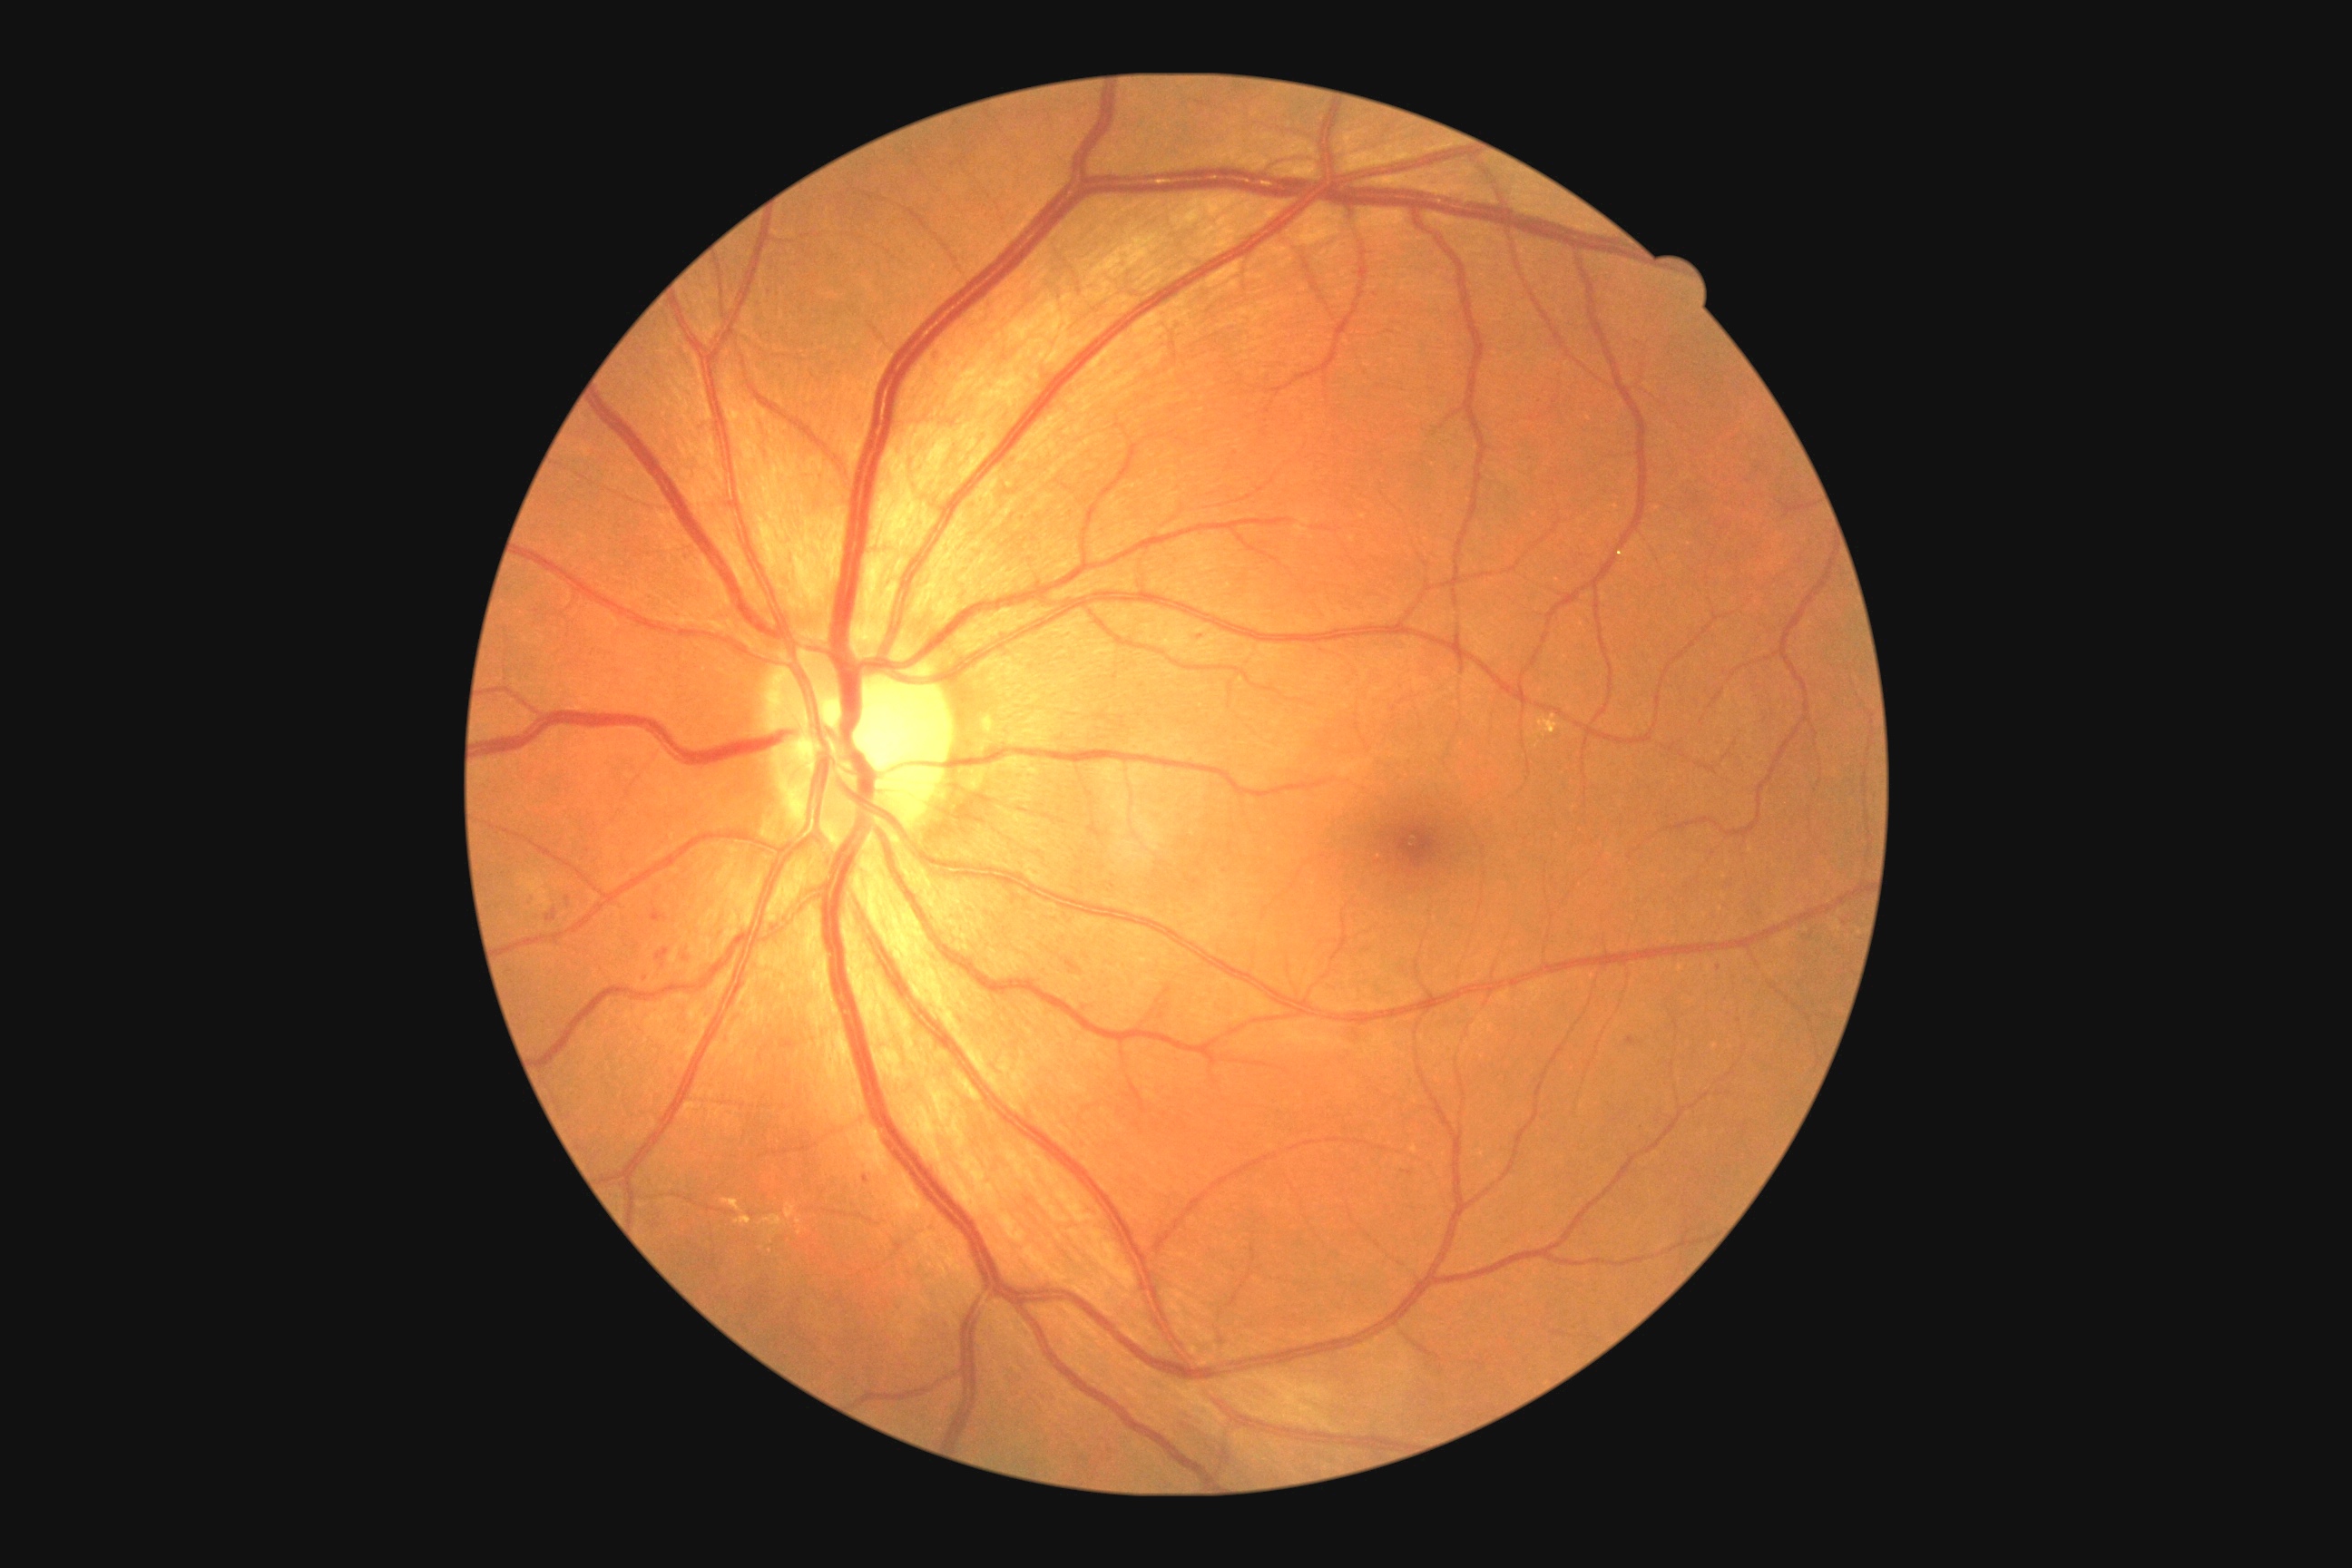 Diabetic retinopathy is moderate non-proliferative diabetic retinopathy (grade 2) — more than just microaneurysms but less than severe NPDR
A subset of detected lesions:
soft exudates: none
hard exudates (more not shown): [734,1215,752,1226] | [1534,714,1560,738] | [721,1199,743,1213] | [787,1202,796,1219] | [760,1215,787,1235]
Small hard exudates approximately at <point>770, 1251</point> | <point>799, 1221</point> | <point>1537, 746</point> | <point>800, 1232</point>
microaneurysms: [1199,634,1208,643] | [1627,1037,1636,1044] | [865,1175,870,1184] | [936,351,946,366]
Small microaneurysms approximately at <point>645, 979</point> | <point>1719, 968</point> | <point>1845, 923</point> | <point>568, 899</point>
hemorrhages: [656,948,671,968] | [1066,959,1083,974] | [545,910,556,923] | [1348,1026,1371,1044] | [652,910,669,923] | [680,948,692,968]